Wide-field contact fundus photograph of an infant
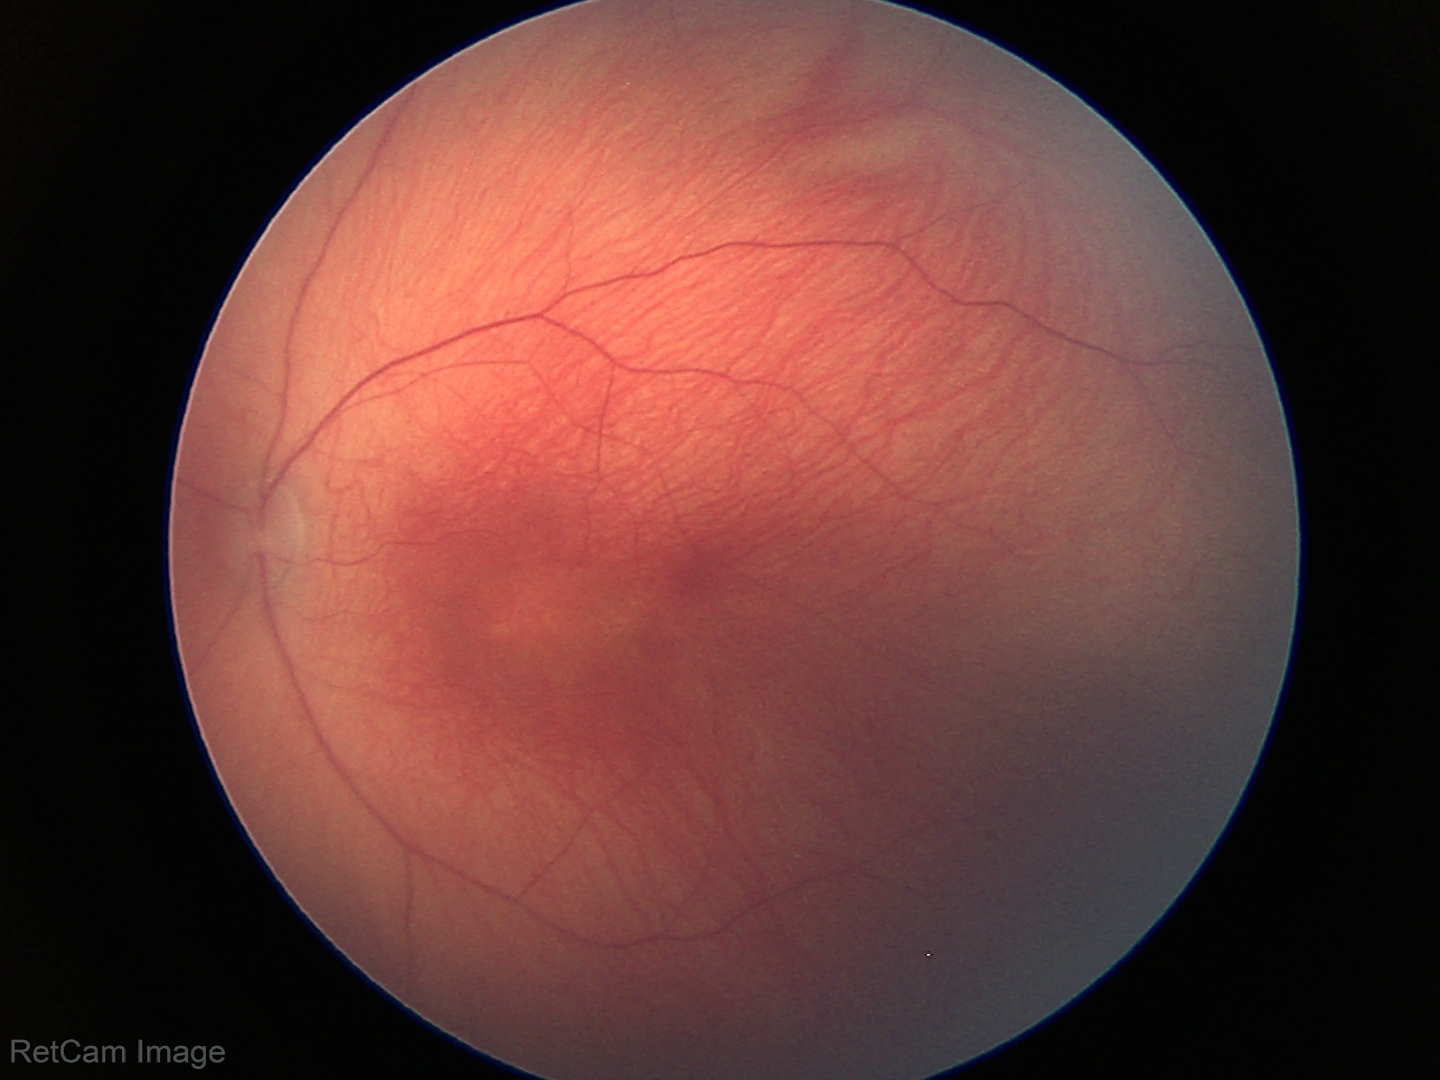
Screening: status post retinopathy of prematurity.